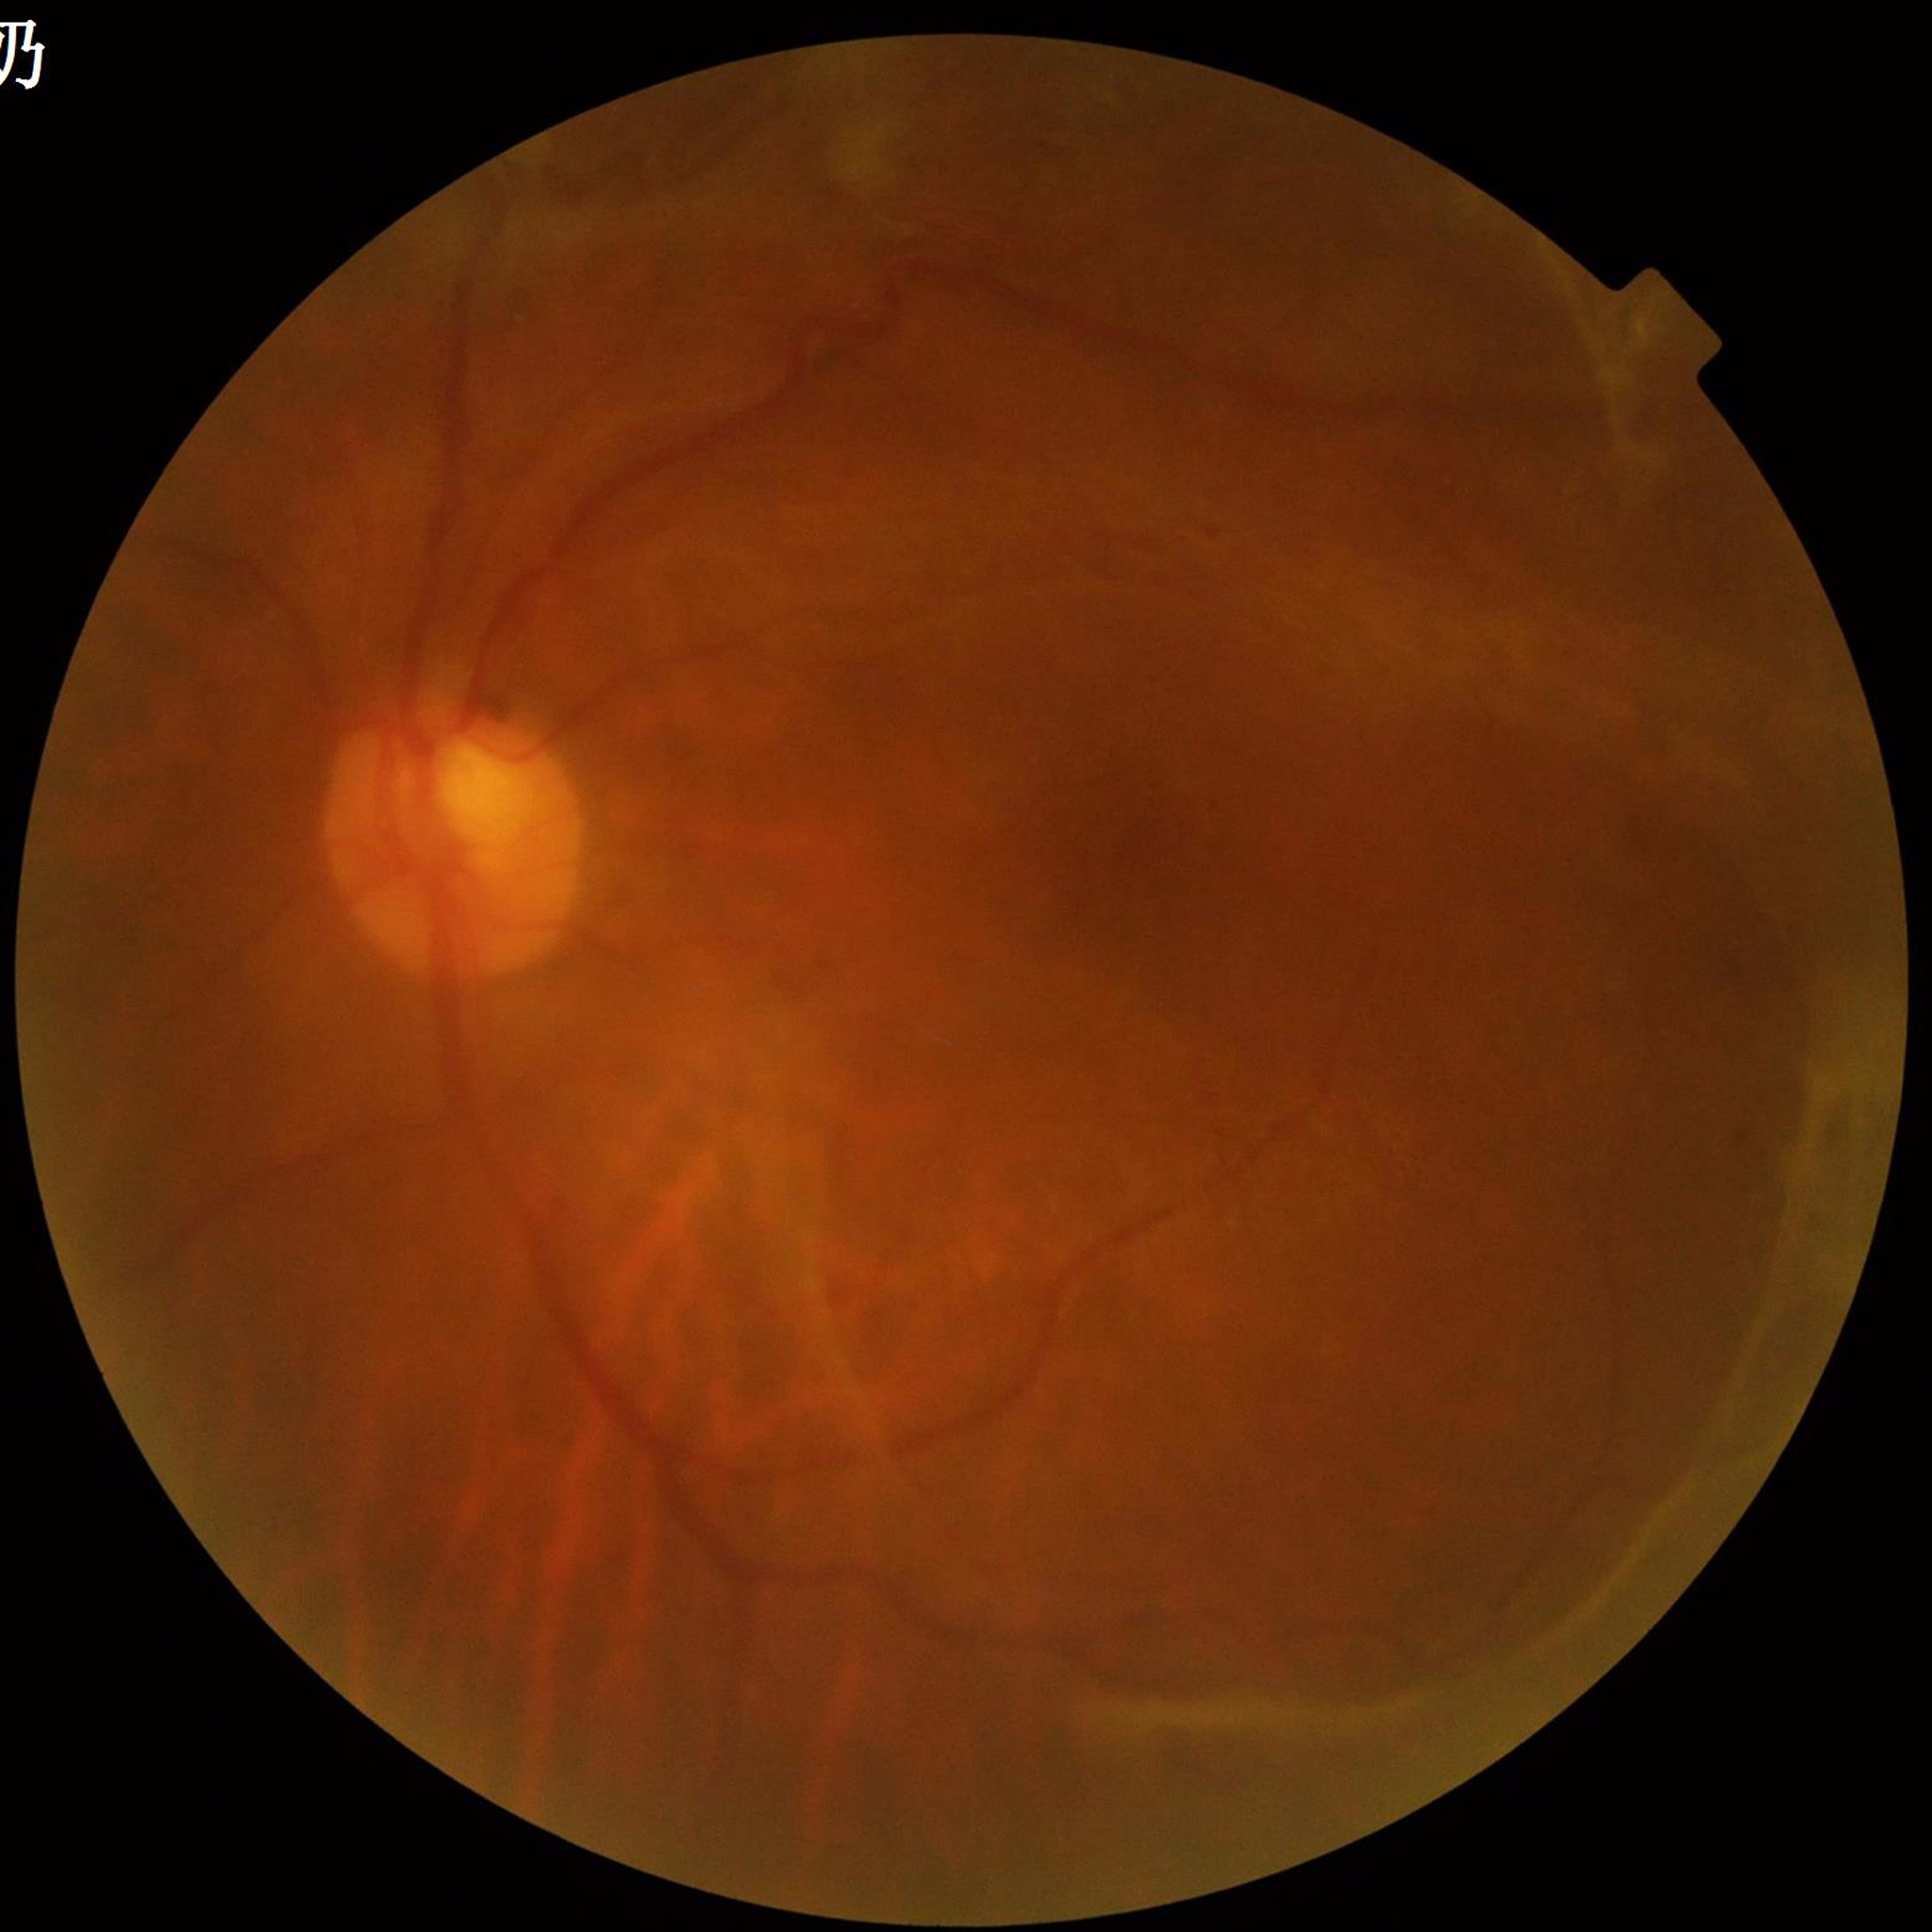
Eye affected by diabetic retinopathy (DR).
Photo quality: concerns include blur.